2228 x 1652 pixels. Dilated-pupil acquisition. Camera: Topcon TRC-50DX
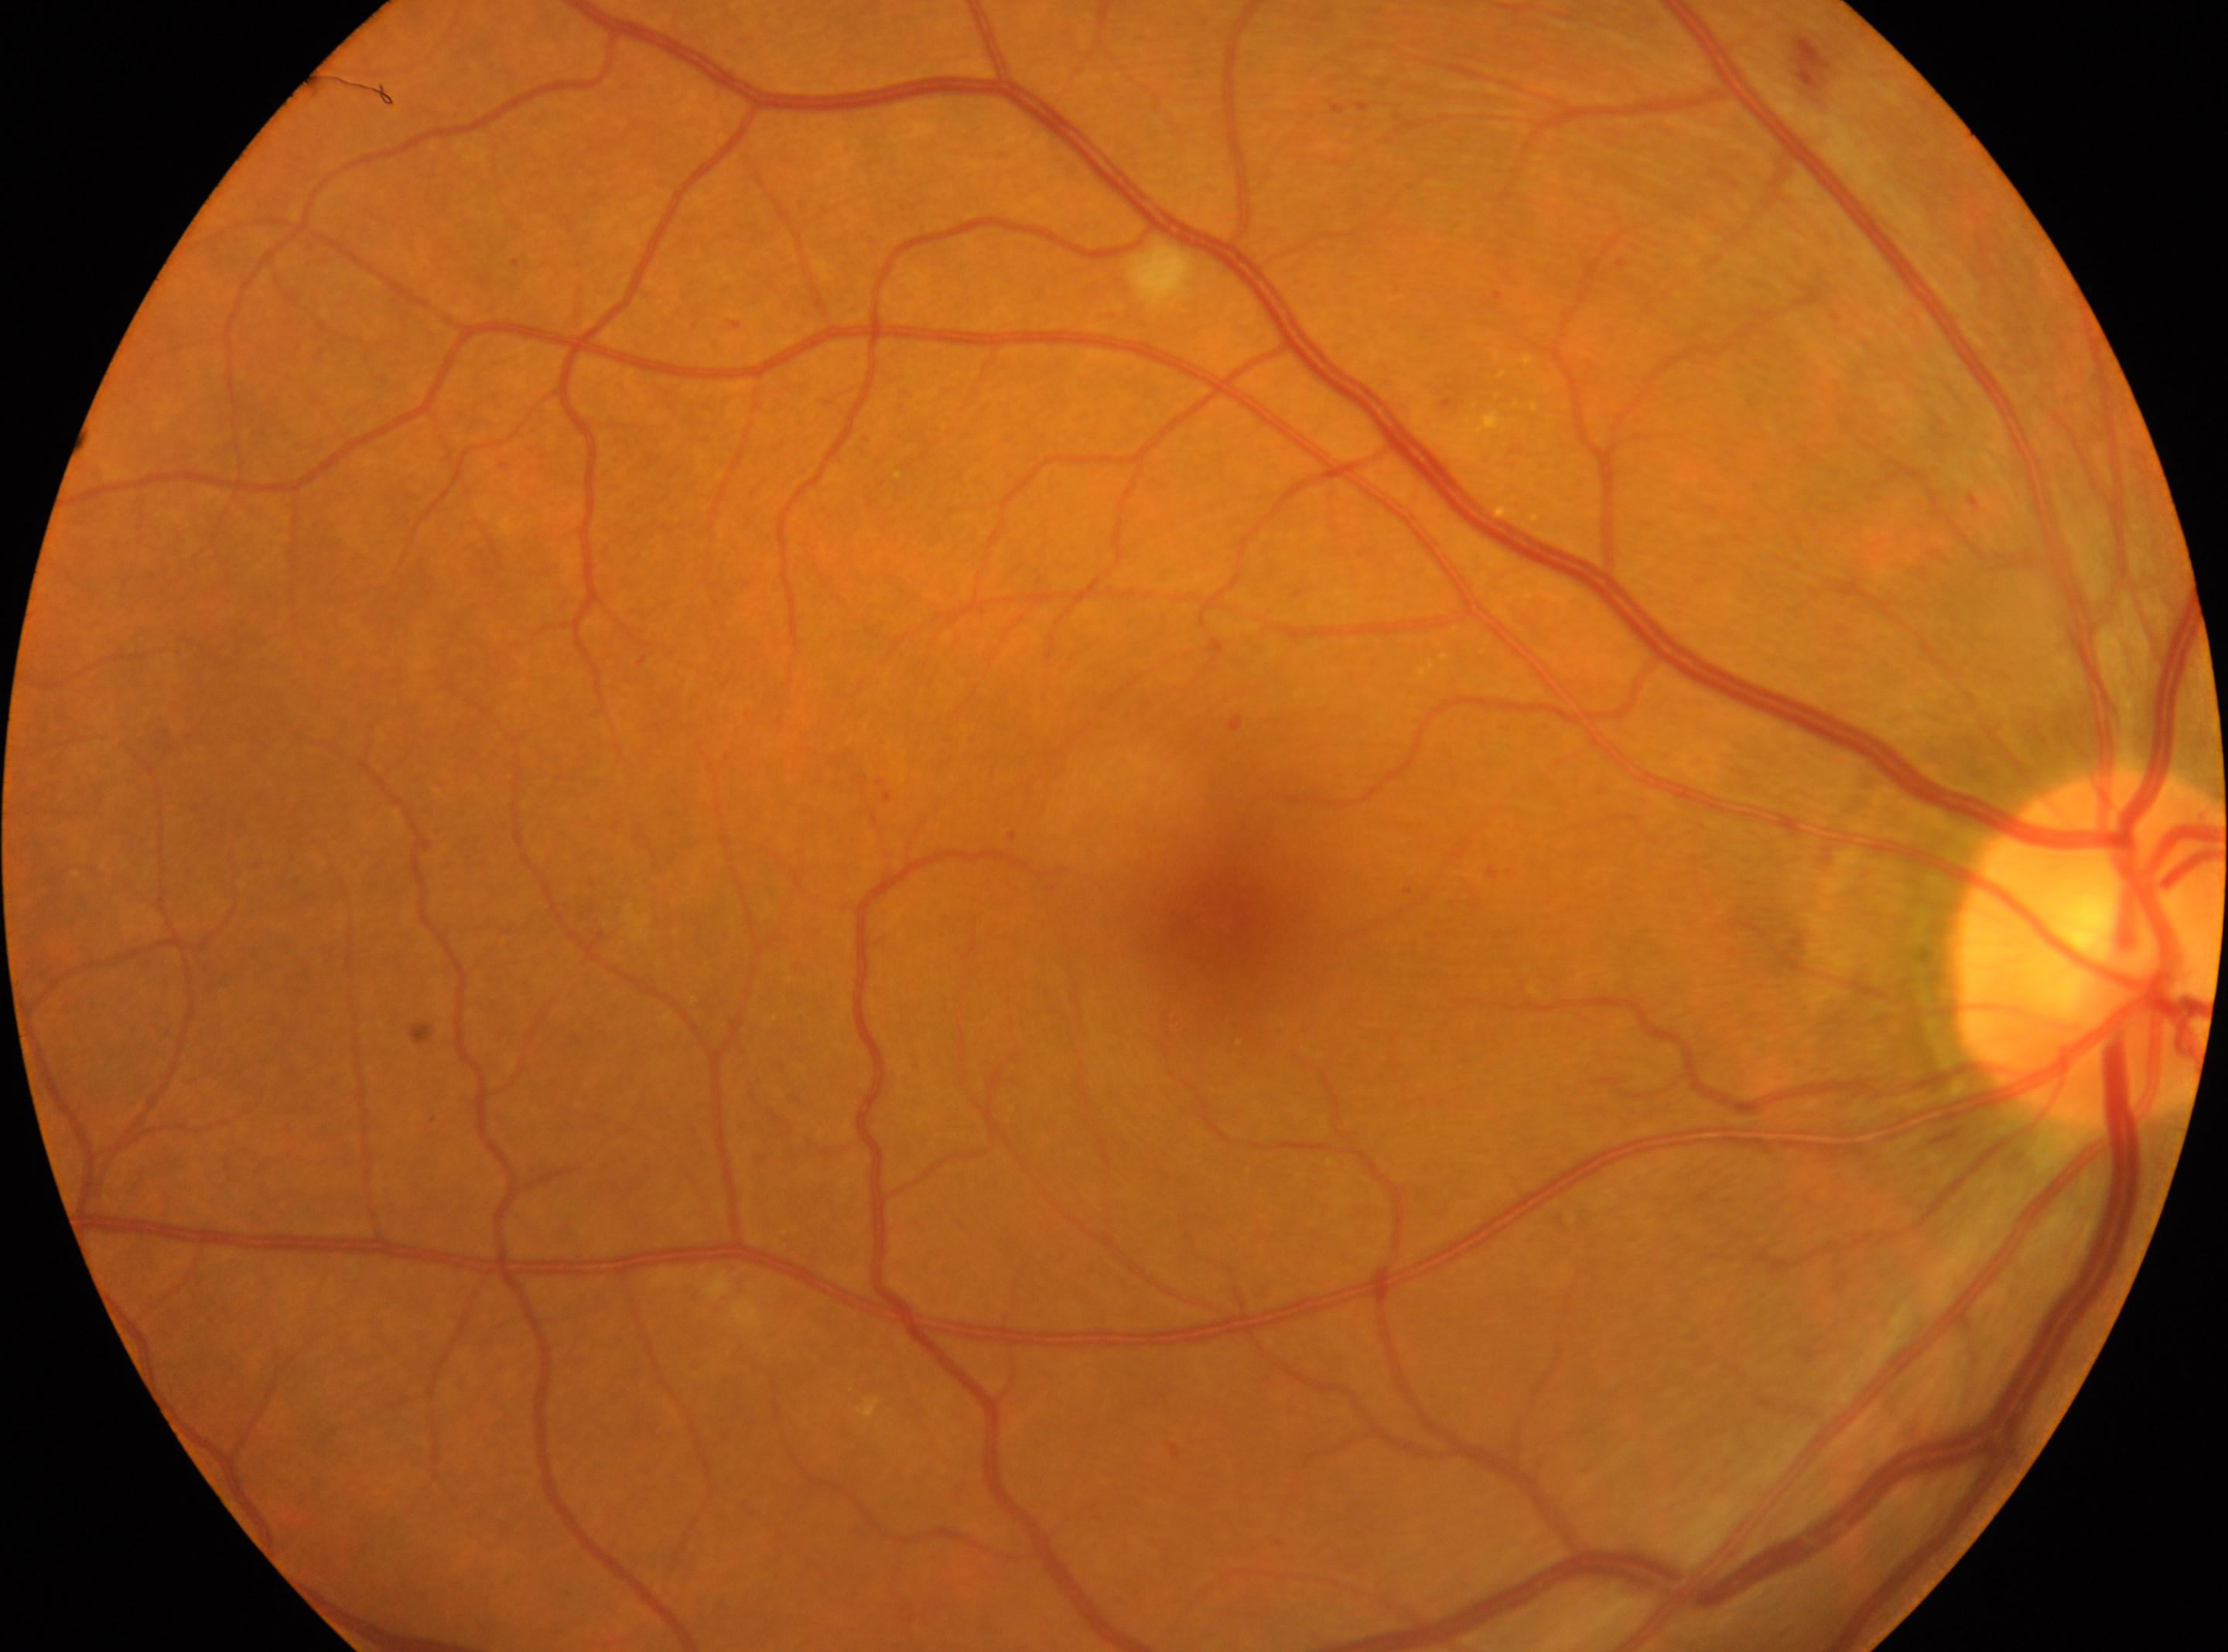
foveal center = (x: 1215, y: 917); optic disc center = (x: 2090, y: 947); DR class = non-proliferative diabetic retinopathy; retinopathy grade = moderate NPDR (2); laterality = the right eye.